Pediatric wide-field fundus photograph · 640 x 480 pixels · camera: Clarity RetCam 3 (130° FOV)
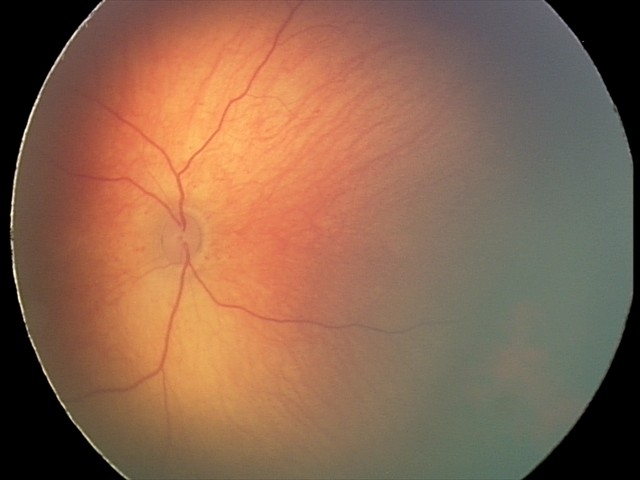 Examination diagnosed as retinal hemorrhages.